45-degree field of view — 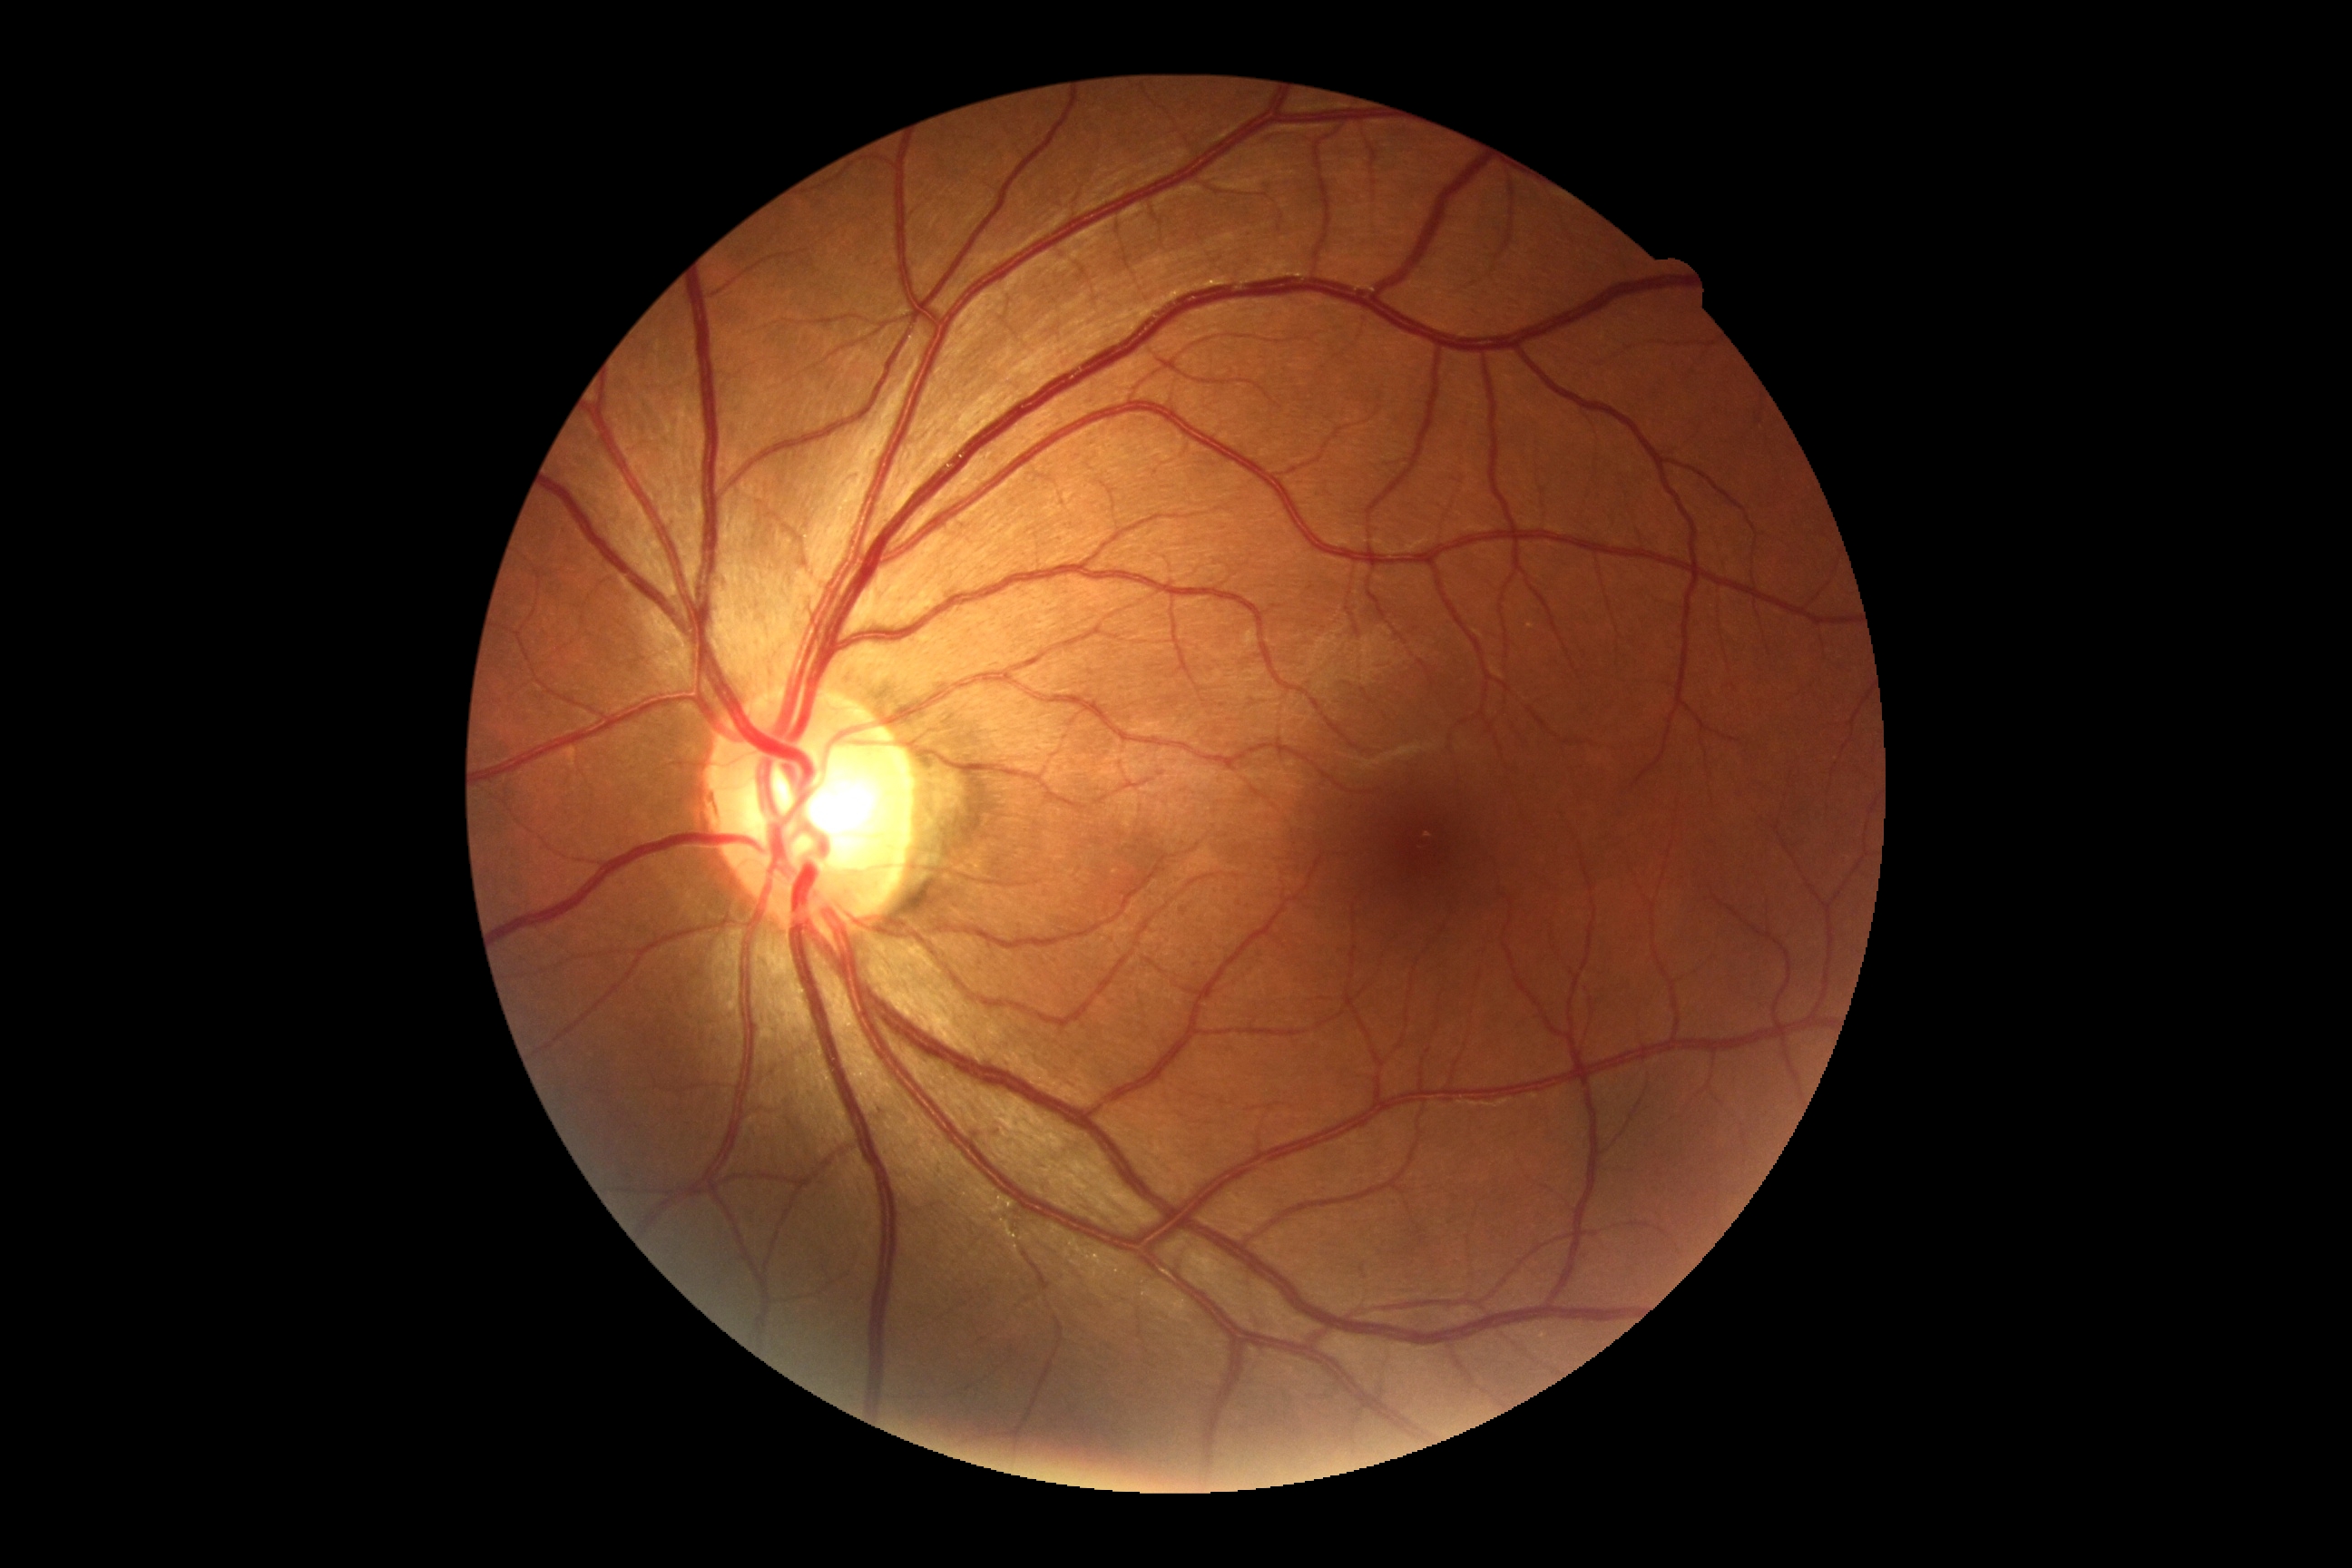

No diabetic retinal disease findings. Retinopathy grade: 0/4 — no visible signs of diabetic retinopathy.